640 by 480 pixels · infant wide-field retinal image: 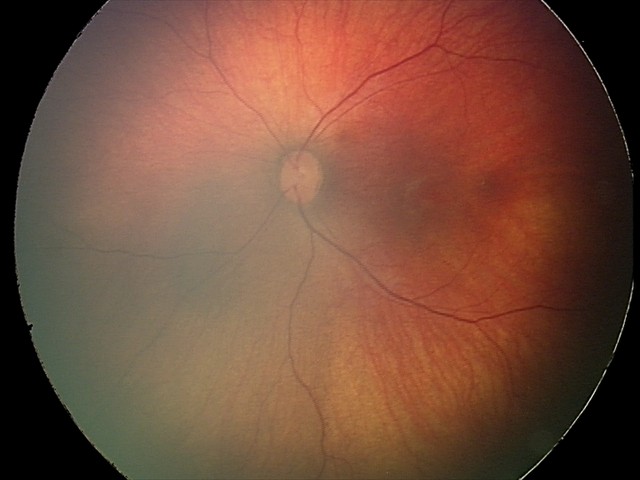
Series diagnosed as retinal hemorrhages.